Macula-centered field: 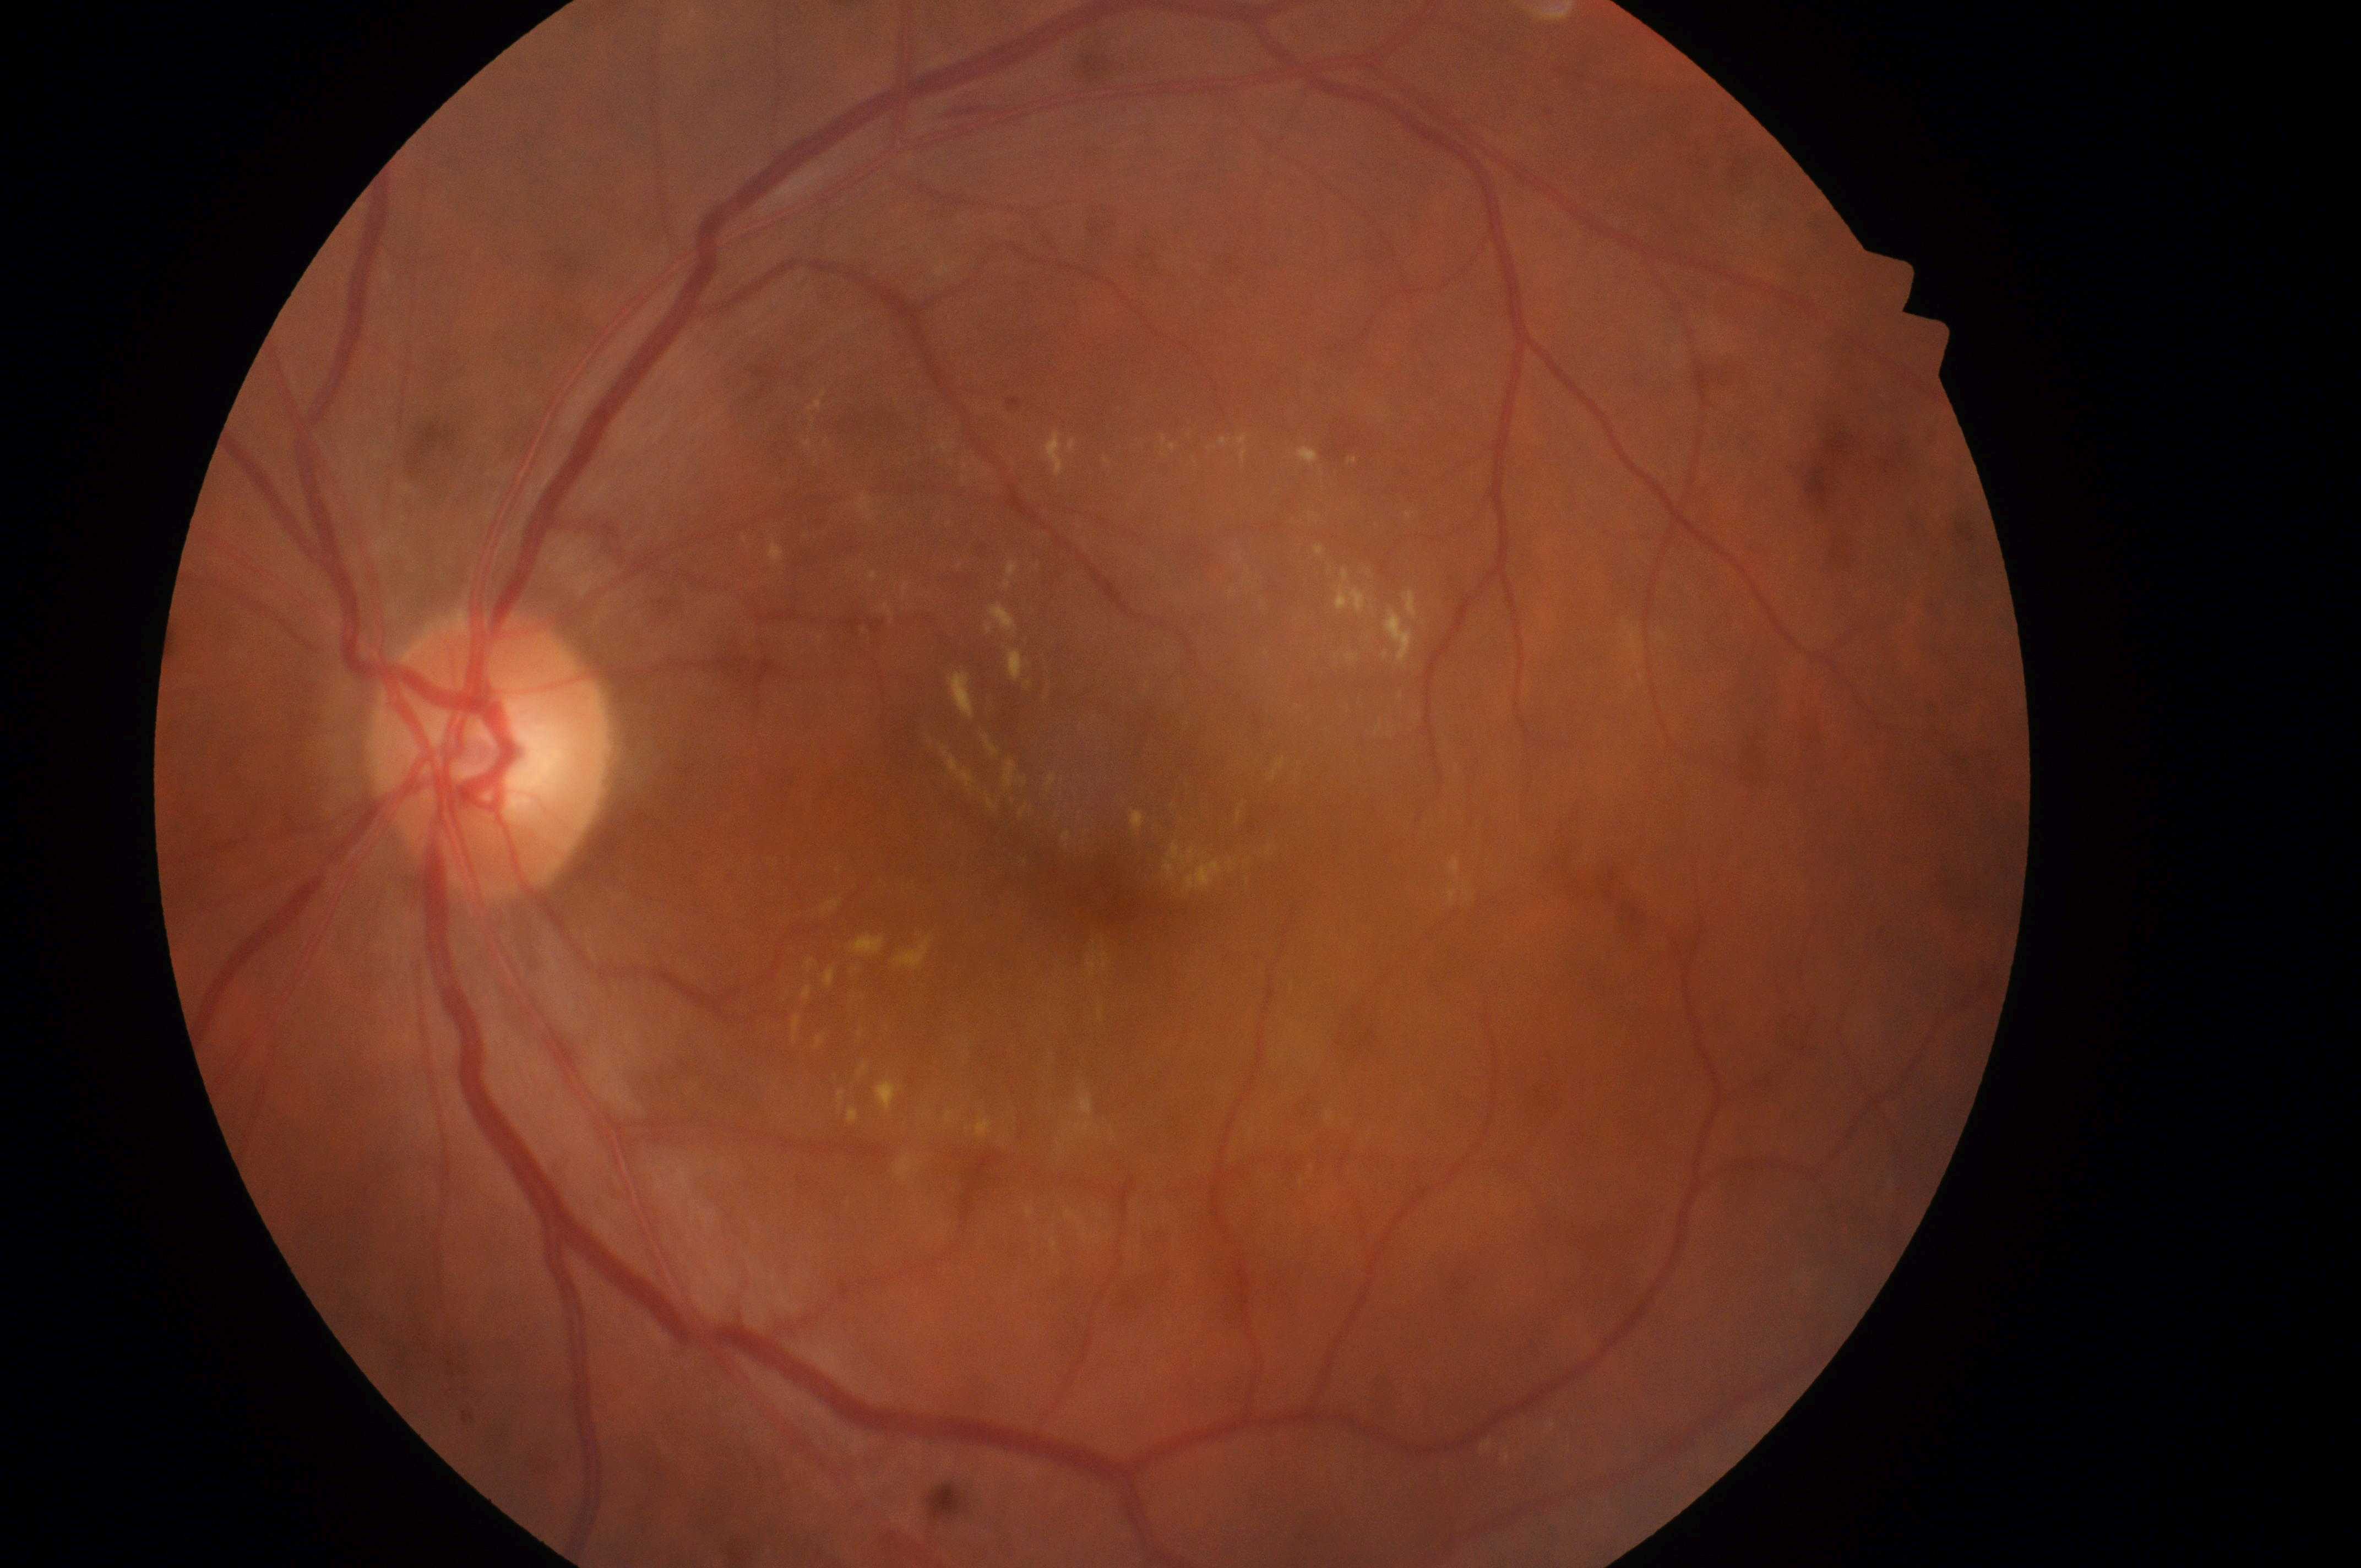 Eye: left eye. DR grade is 2/4. Fovea located at (1112,897). Optic nerve head located at (480,763). DME grade: 2/2.